130° field of view (Natus RetCam Envision); 1440x1080px; pediatric wide-field fundus photograph.
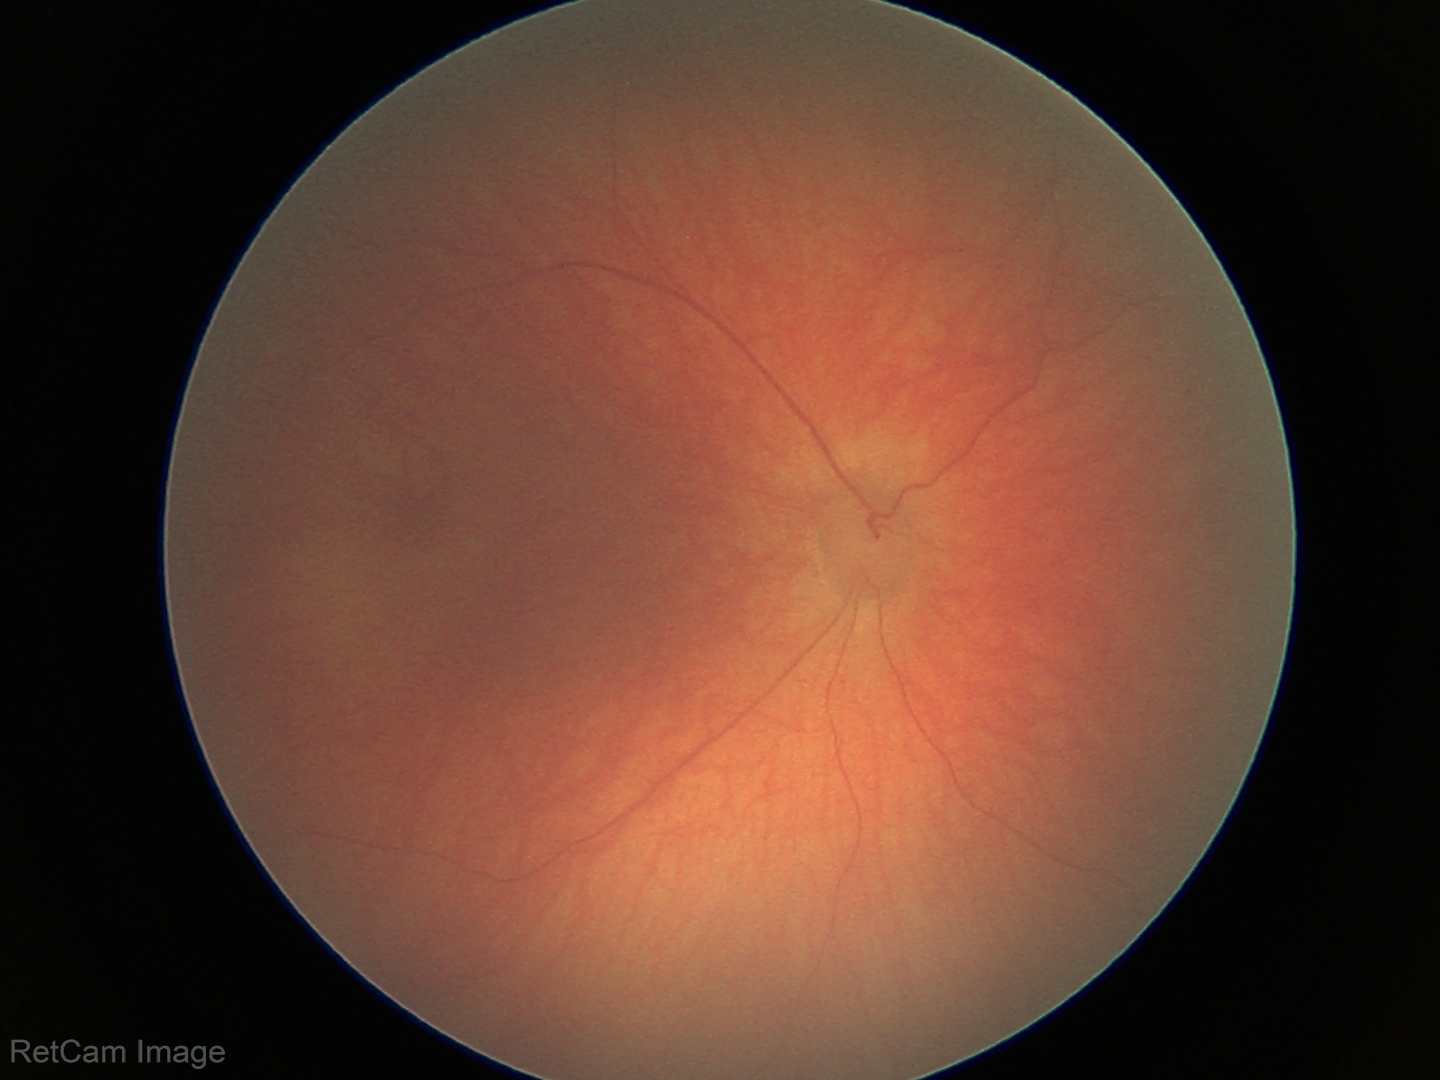

Screening examination with no abnormal retinal findings.